Without pupil dilation
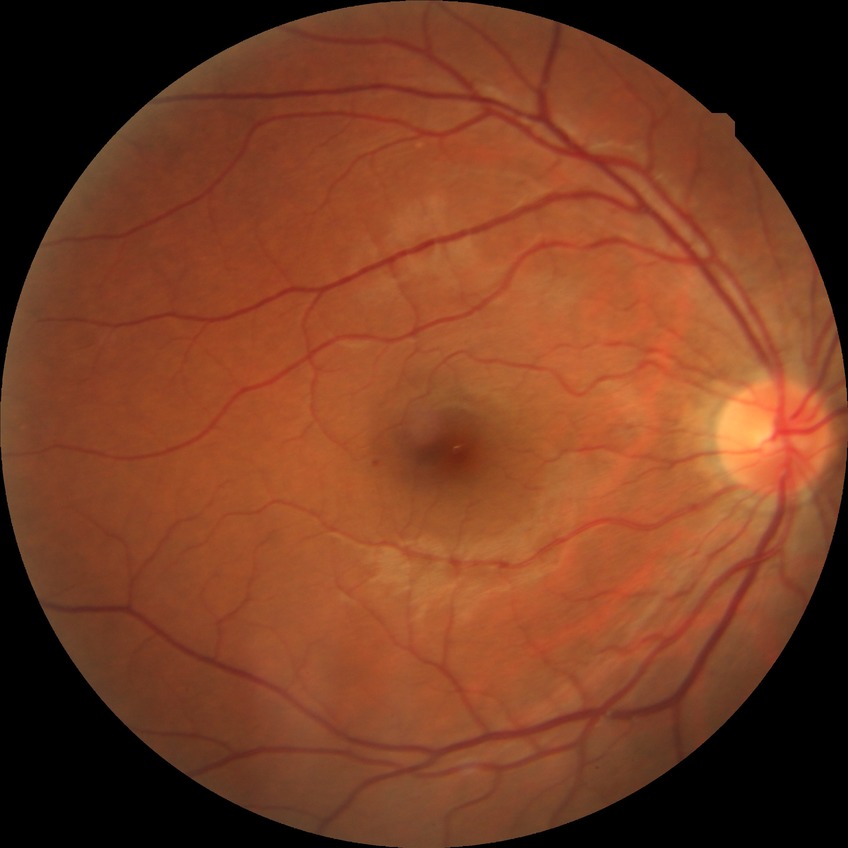

diabetic retinopathy stage = simple diabetic retinopathy.